45° FOV · fundus photo · image size 2346x1568
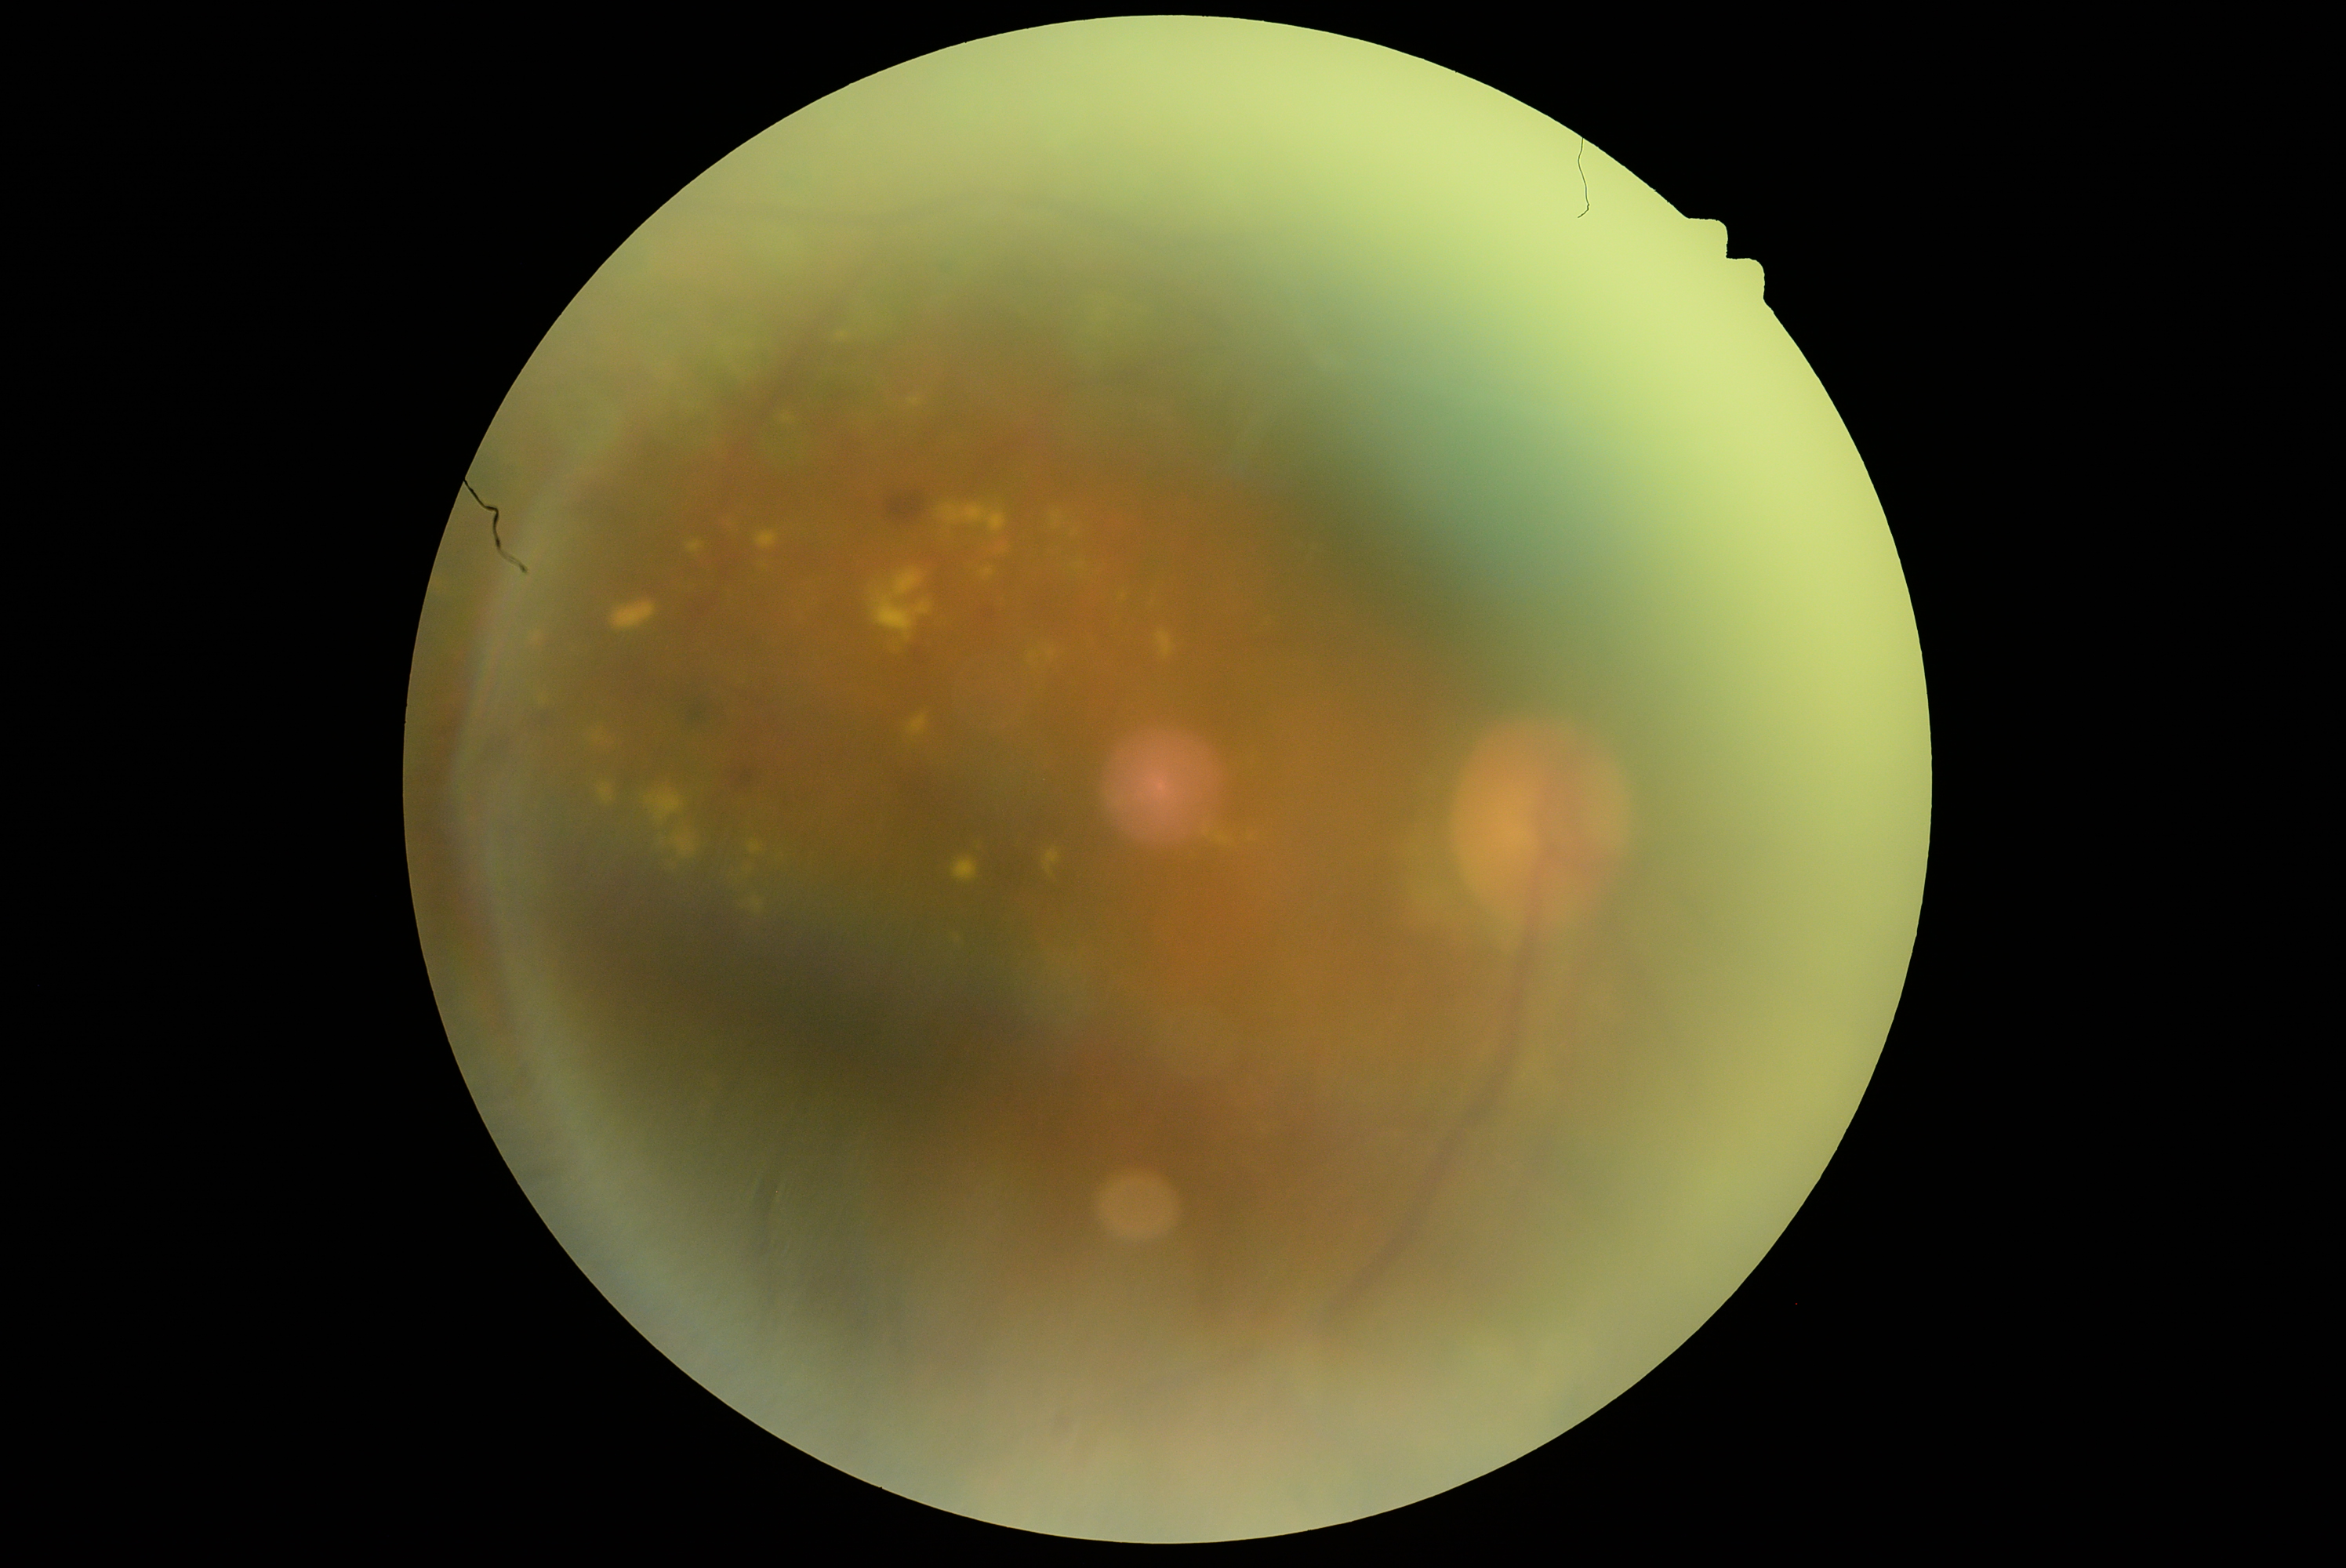
retinopathy grade = 2/4, DR class = non-proliferative diabetic retinopathy.